848 by 848 pixels.
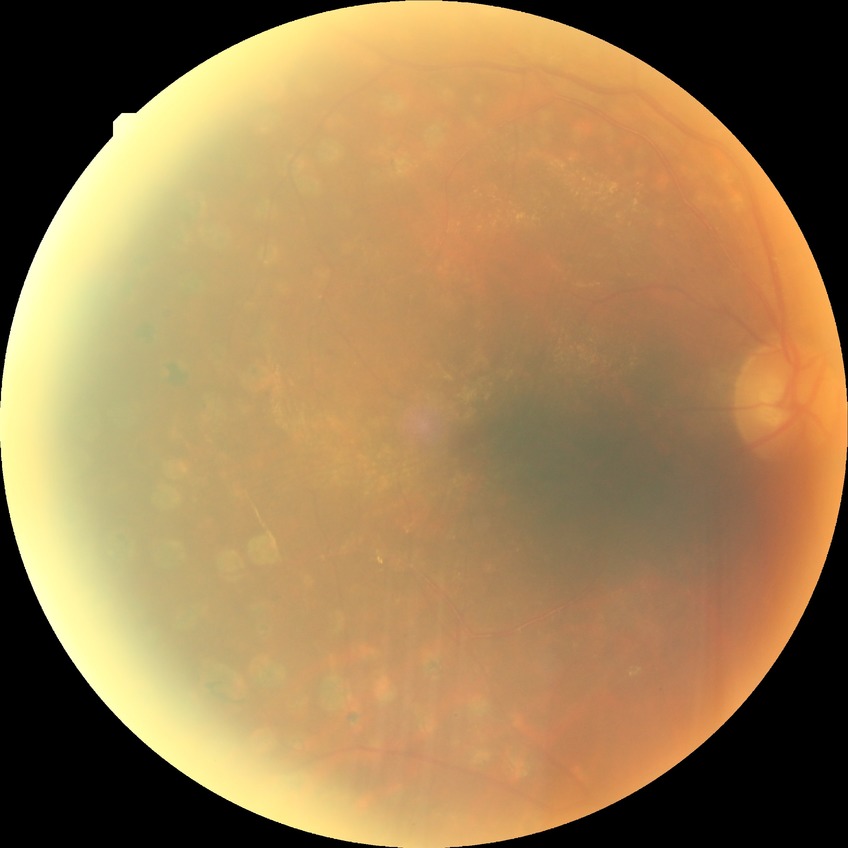

Modified Davis grade is PDR.